45° FOV — 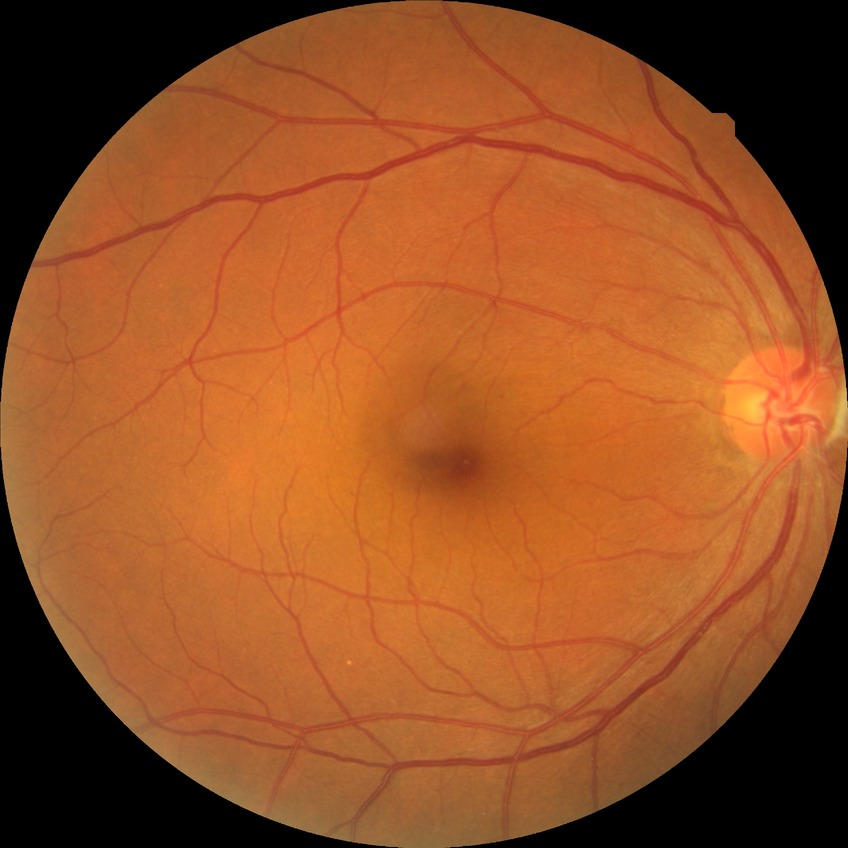
Diabetic retinopathy (DR): NDR (no diabetic retinopathy).